1659x2212
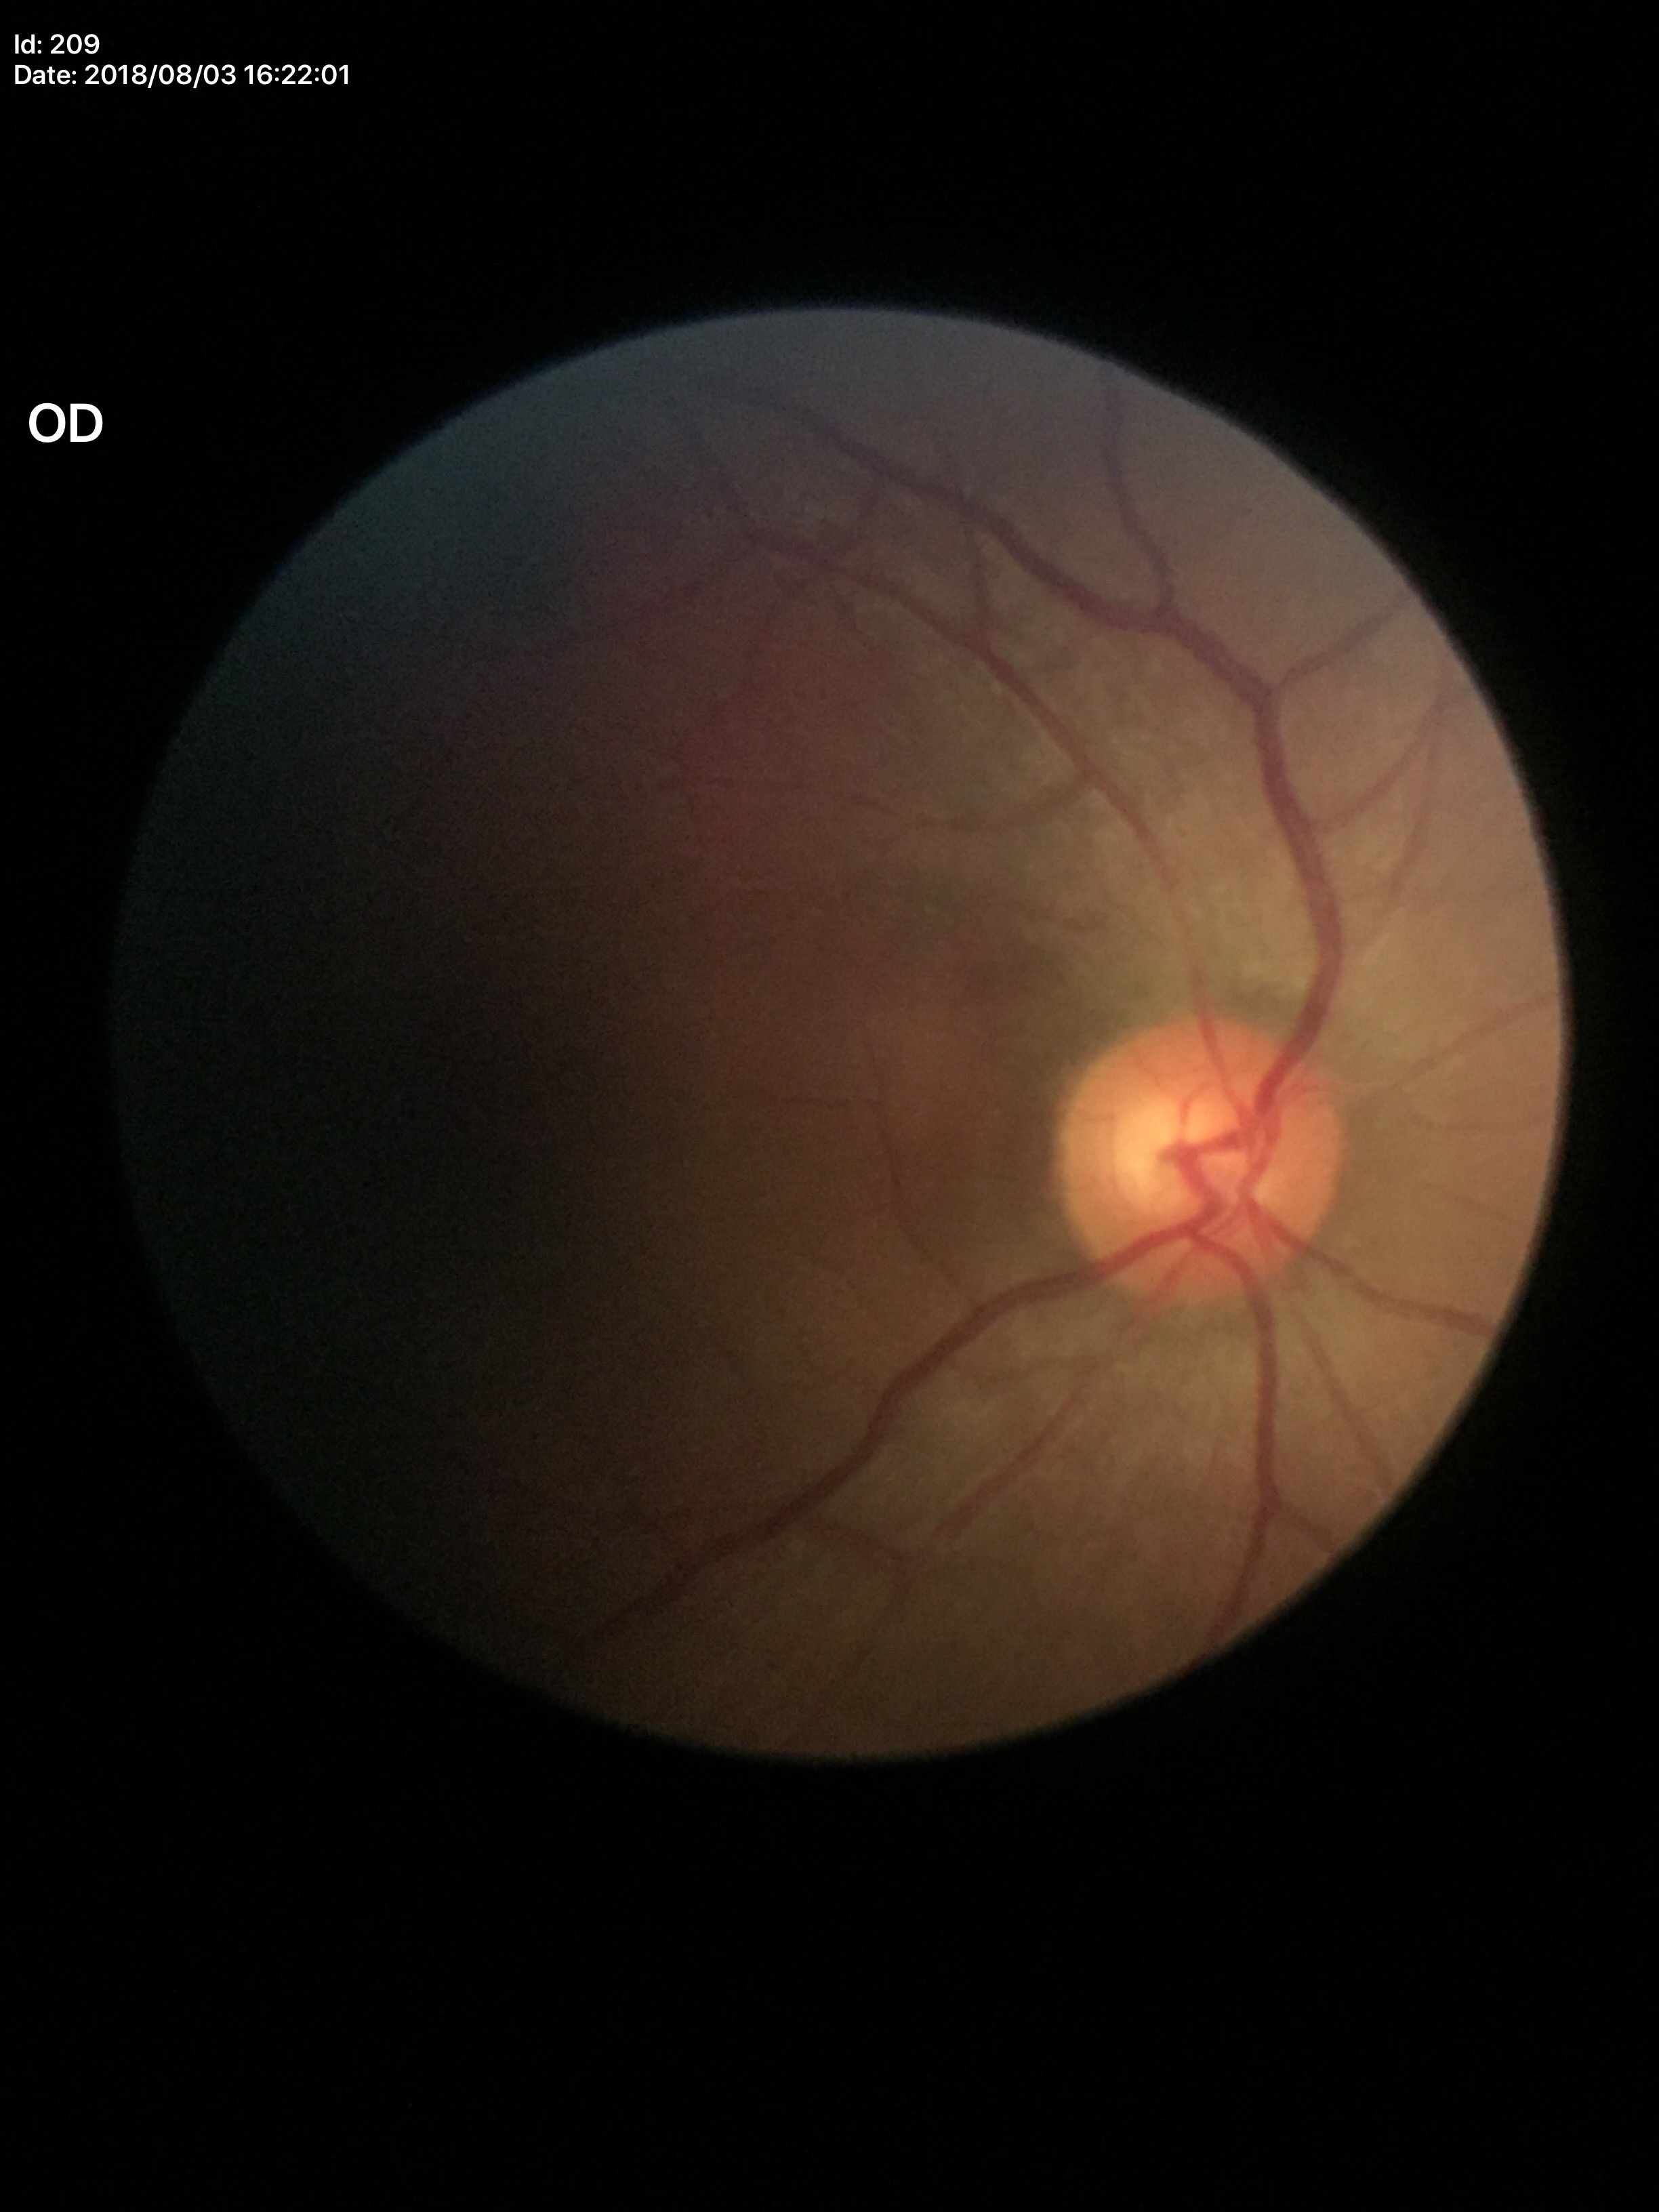 No signs of glaucoma (1/5 graders called glaucoma suspect).
Vertical CDR of 0.50.